45° FOV, color fundus photograph, nonmydriatic fundus photograph, NIDEK AFC-230
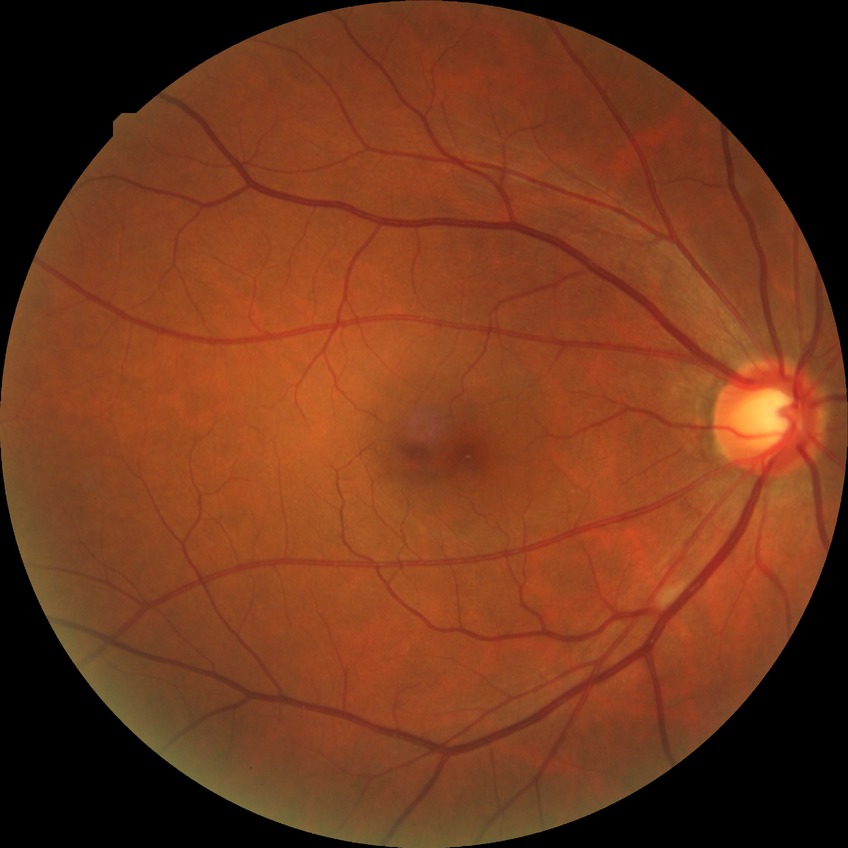

Diabetic retinopathy (DR) is no diabetic retinopathy (NDR).